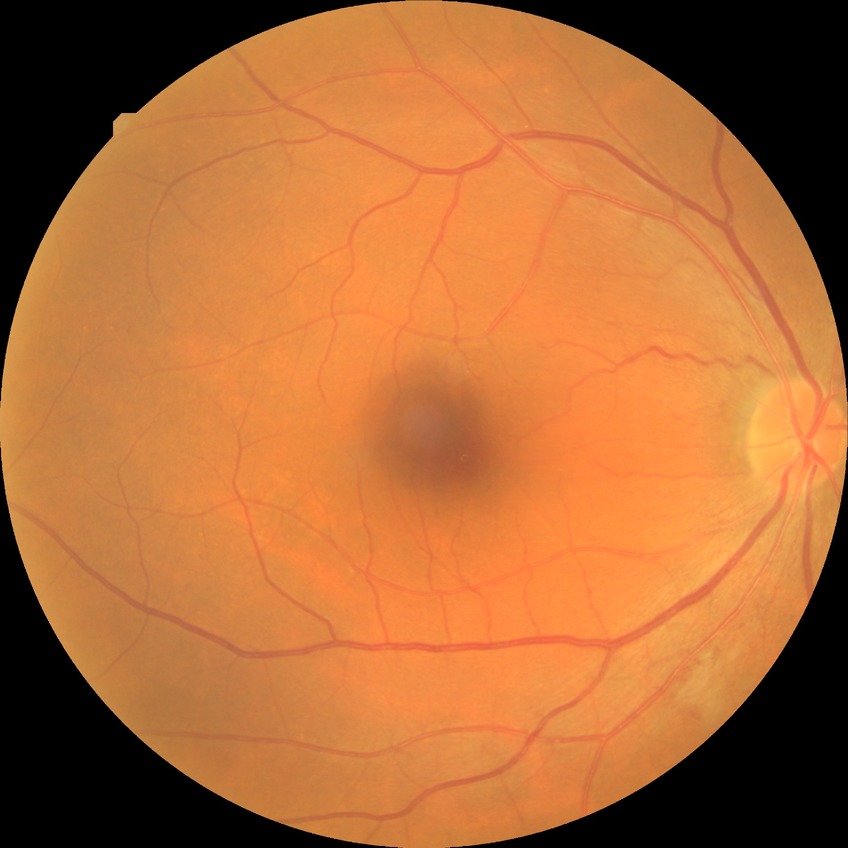

Retinopathy stage: simple diabetic retinopathy.